Image size 512x512; CFP.
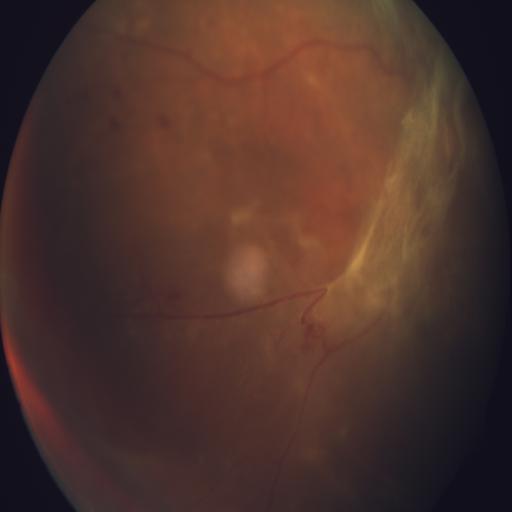

Pathology (2): retinal traction (RT), collateral vessels (CL).